Modified Davis classification. 45 degree fundus photograph. Retinal fundus photograph. Nonmydriatic
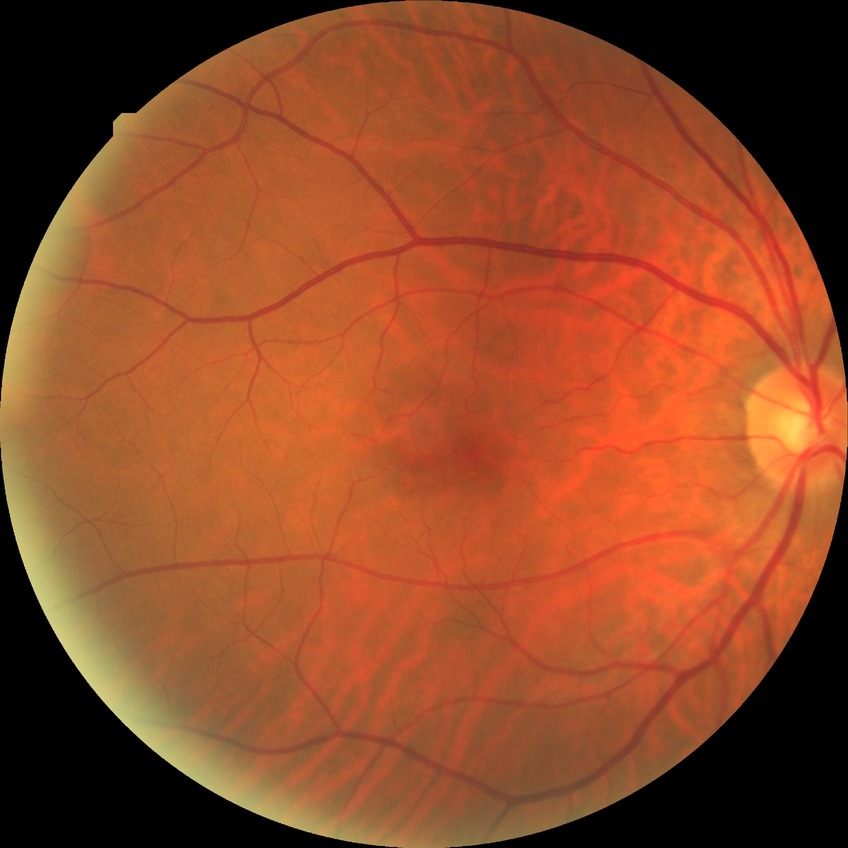 diabetic retinopathy (DR): NDR (no diabetic retinopathy).